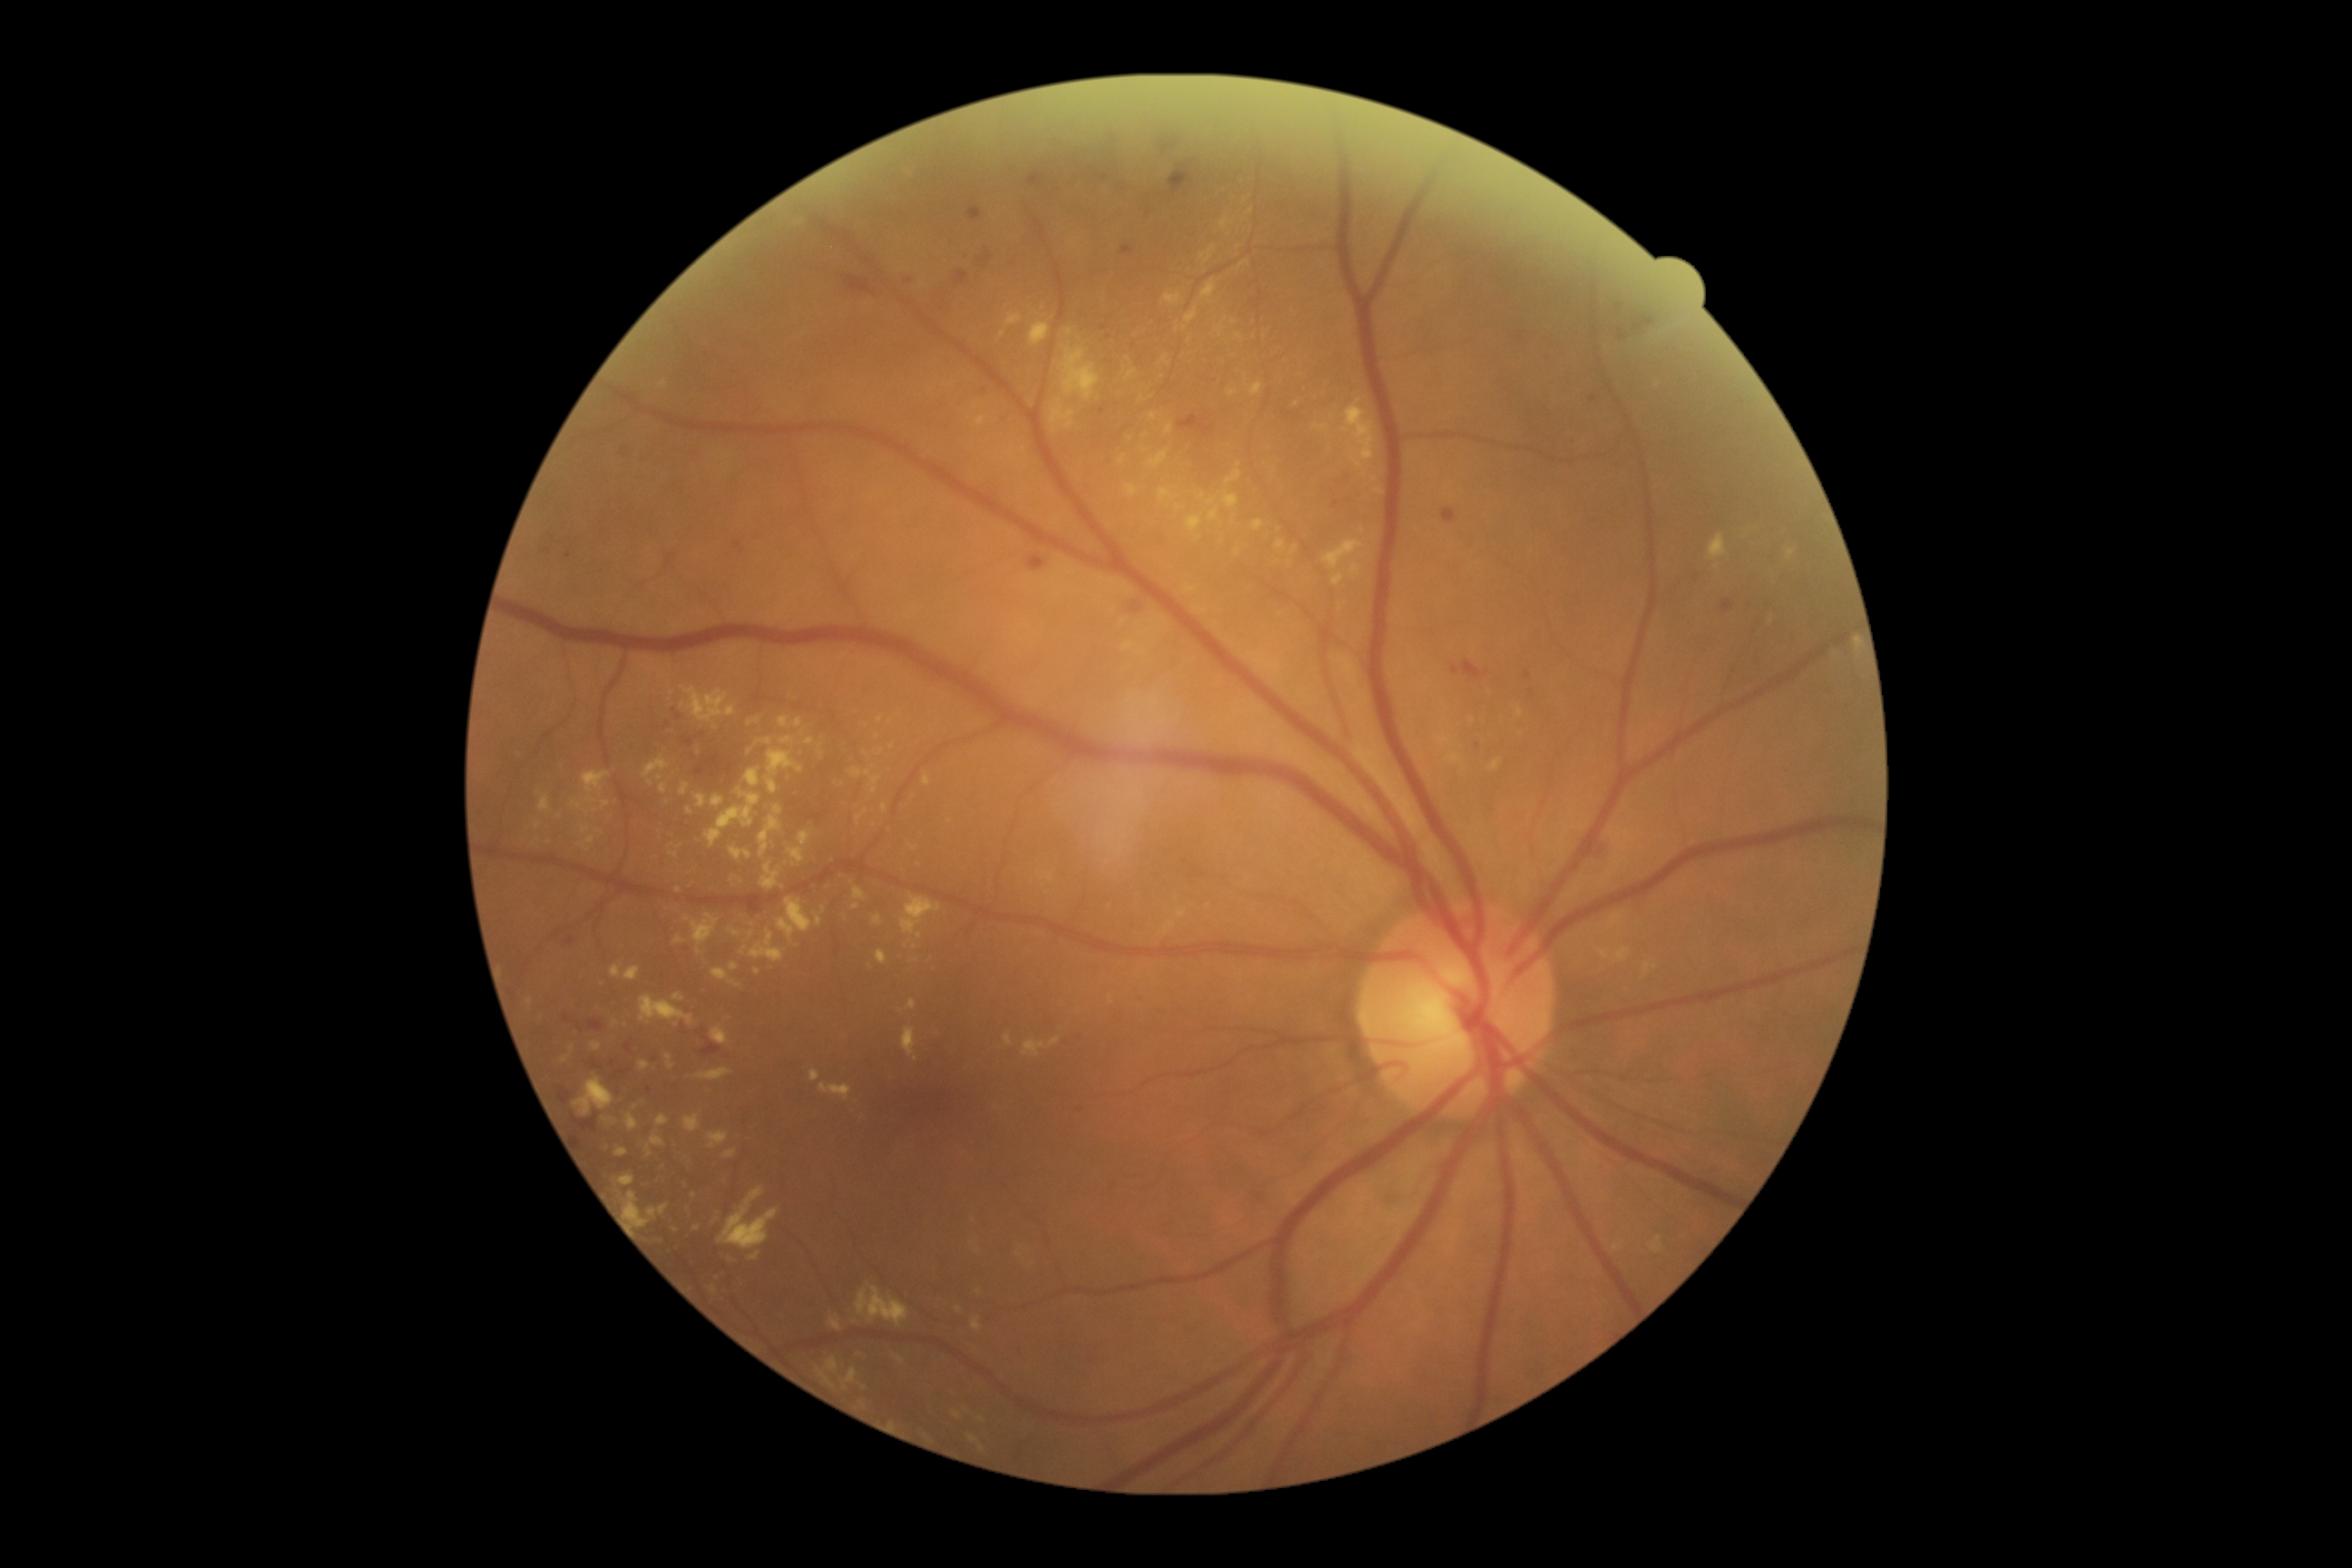
{"partial": true, "dr_grade": 2, "dr_grade_name": "moderate NPDR", "lesions": {"ex": [[1119, 456, 1126, 464], [614, 1146, 629, 1159], [819, 1083, 852, 1101], [1200, 280, 1217, 302], [640, 995, 696, 1026], [1446, 754, 1462, 765], [1787, 549, 1796, 558], [1164, 424, 1173, 435], [712, 796, 725, 807], [1166, 923, 1173, 932], [730, 877, 743, 887], [1159, 489, 1175, 504]], "ex_small": [[1203, 497], [580, 846], [845, 1389], [915, 1059], [959, 1310], [660, 778]]}}